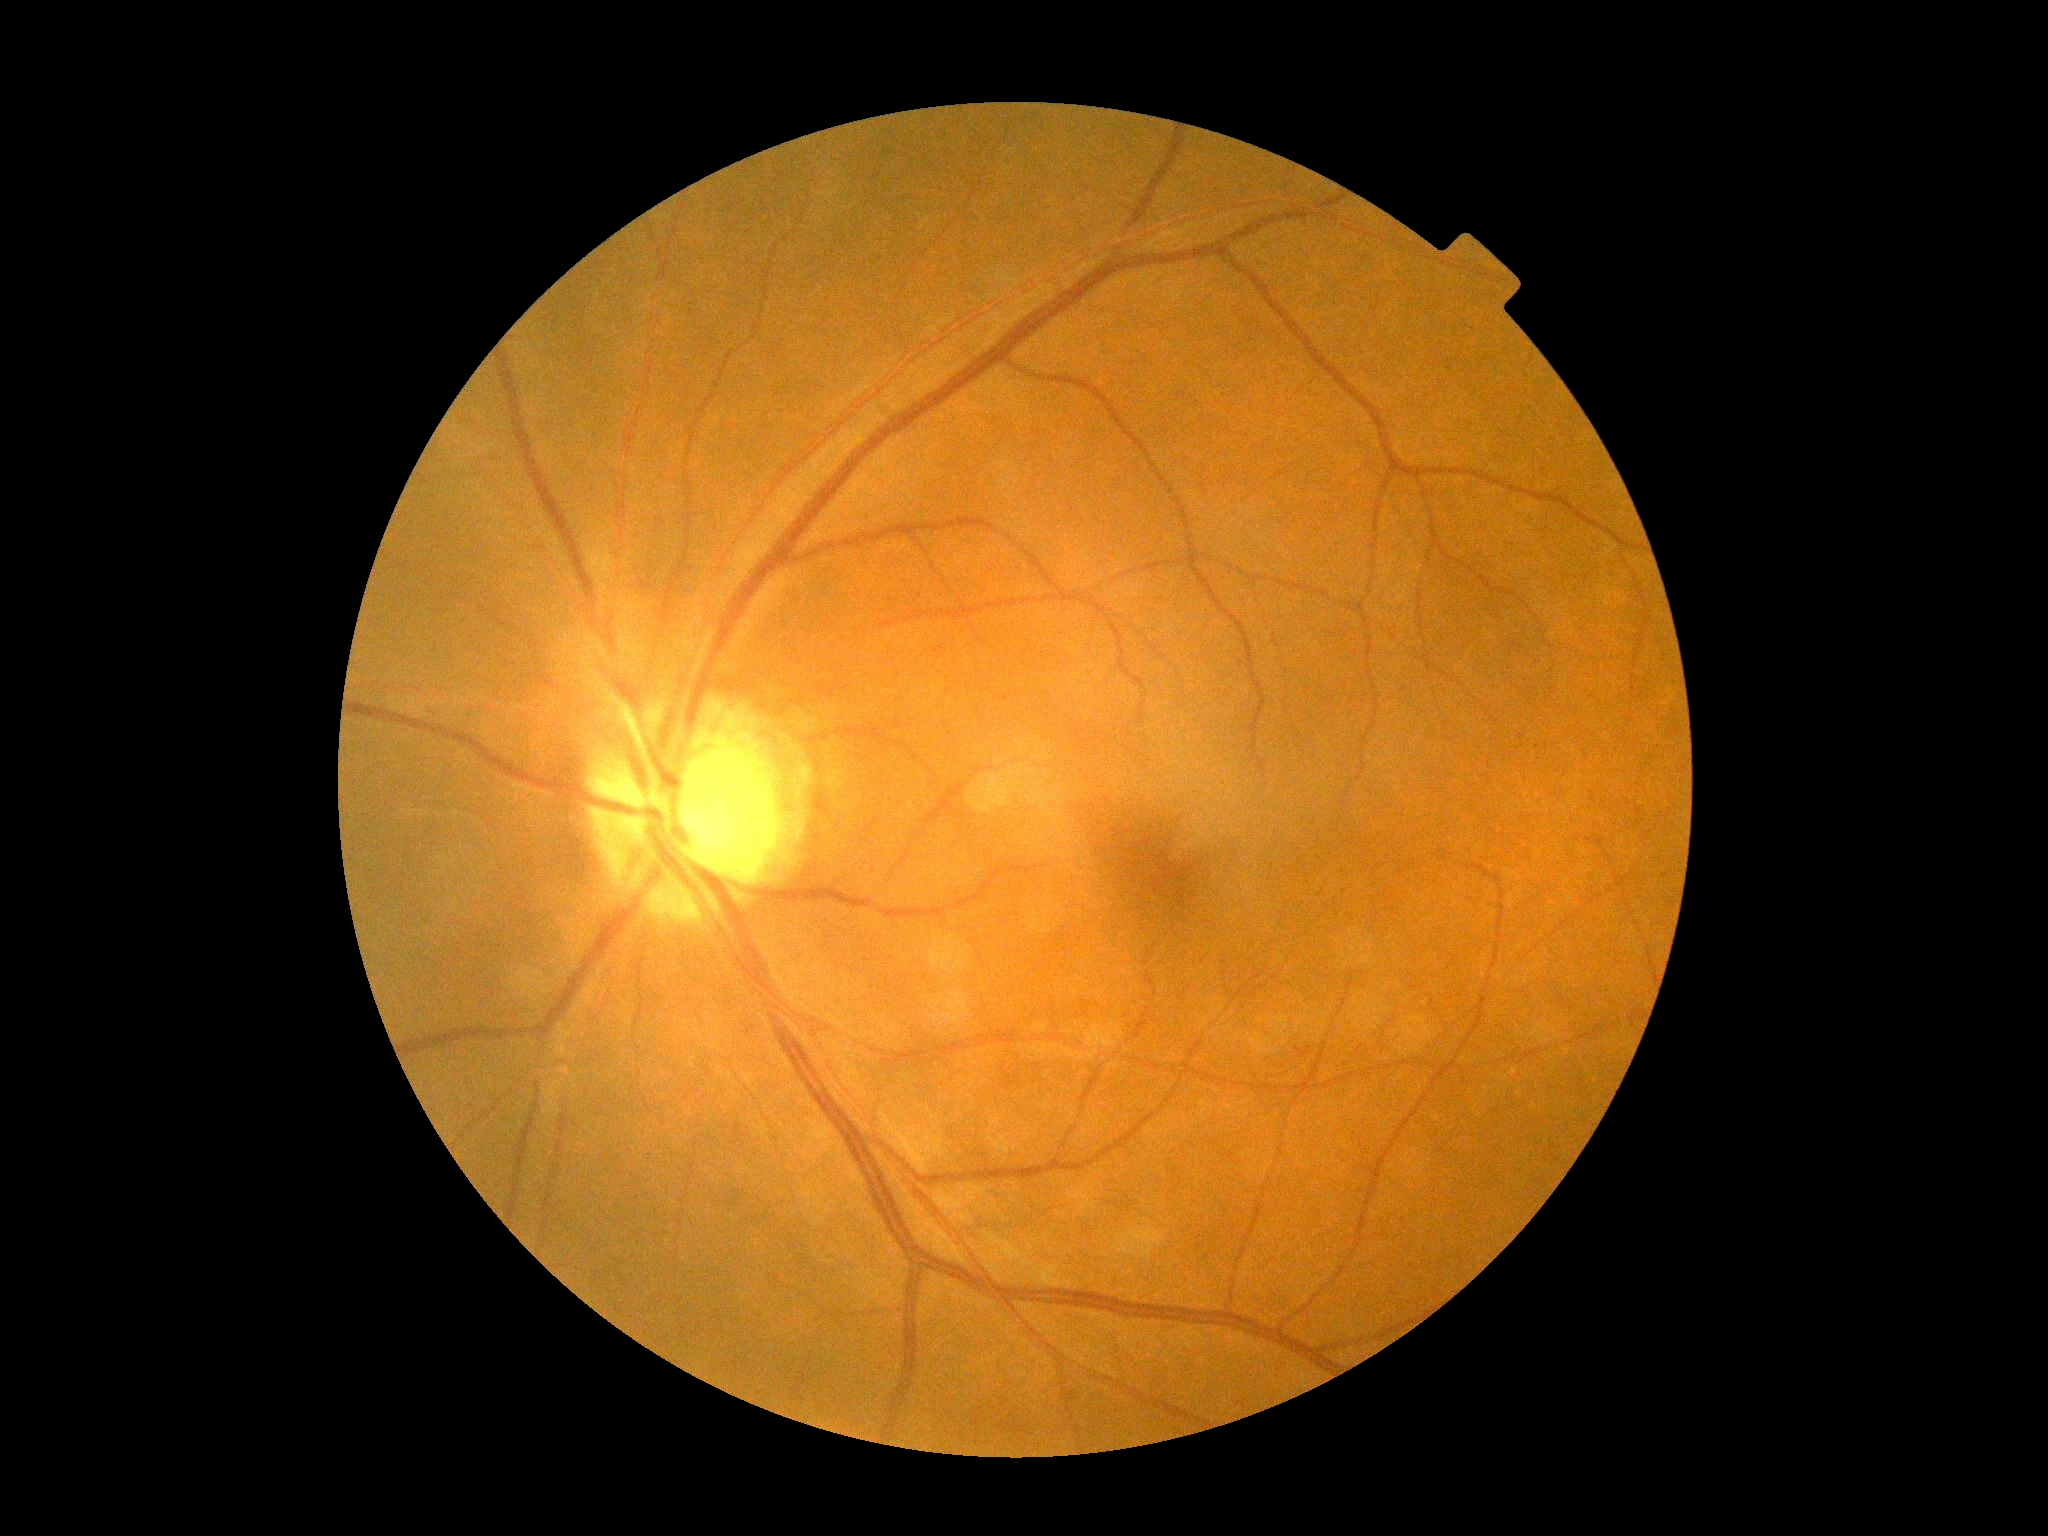

diabetic retinopathy (DR)=0/4.